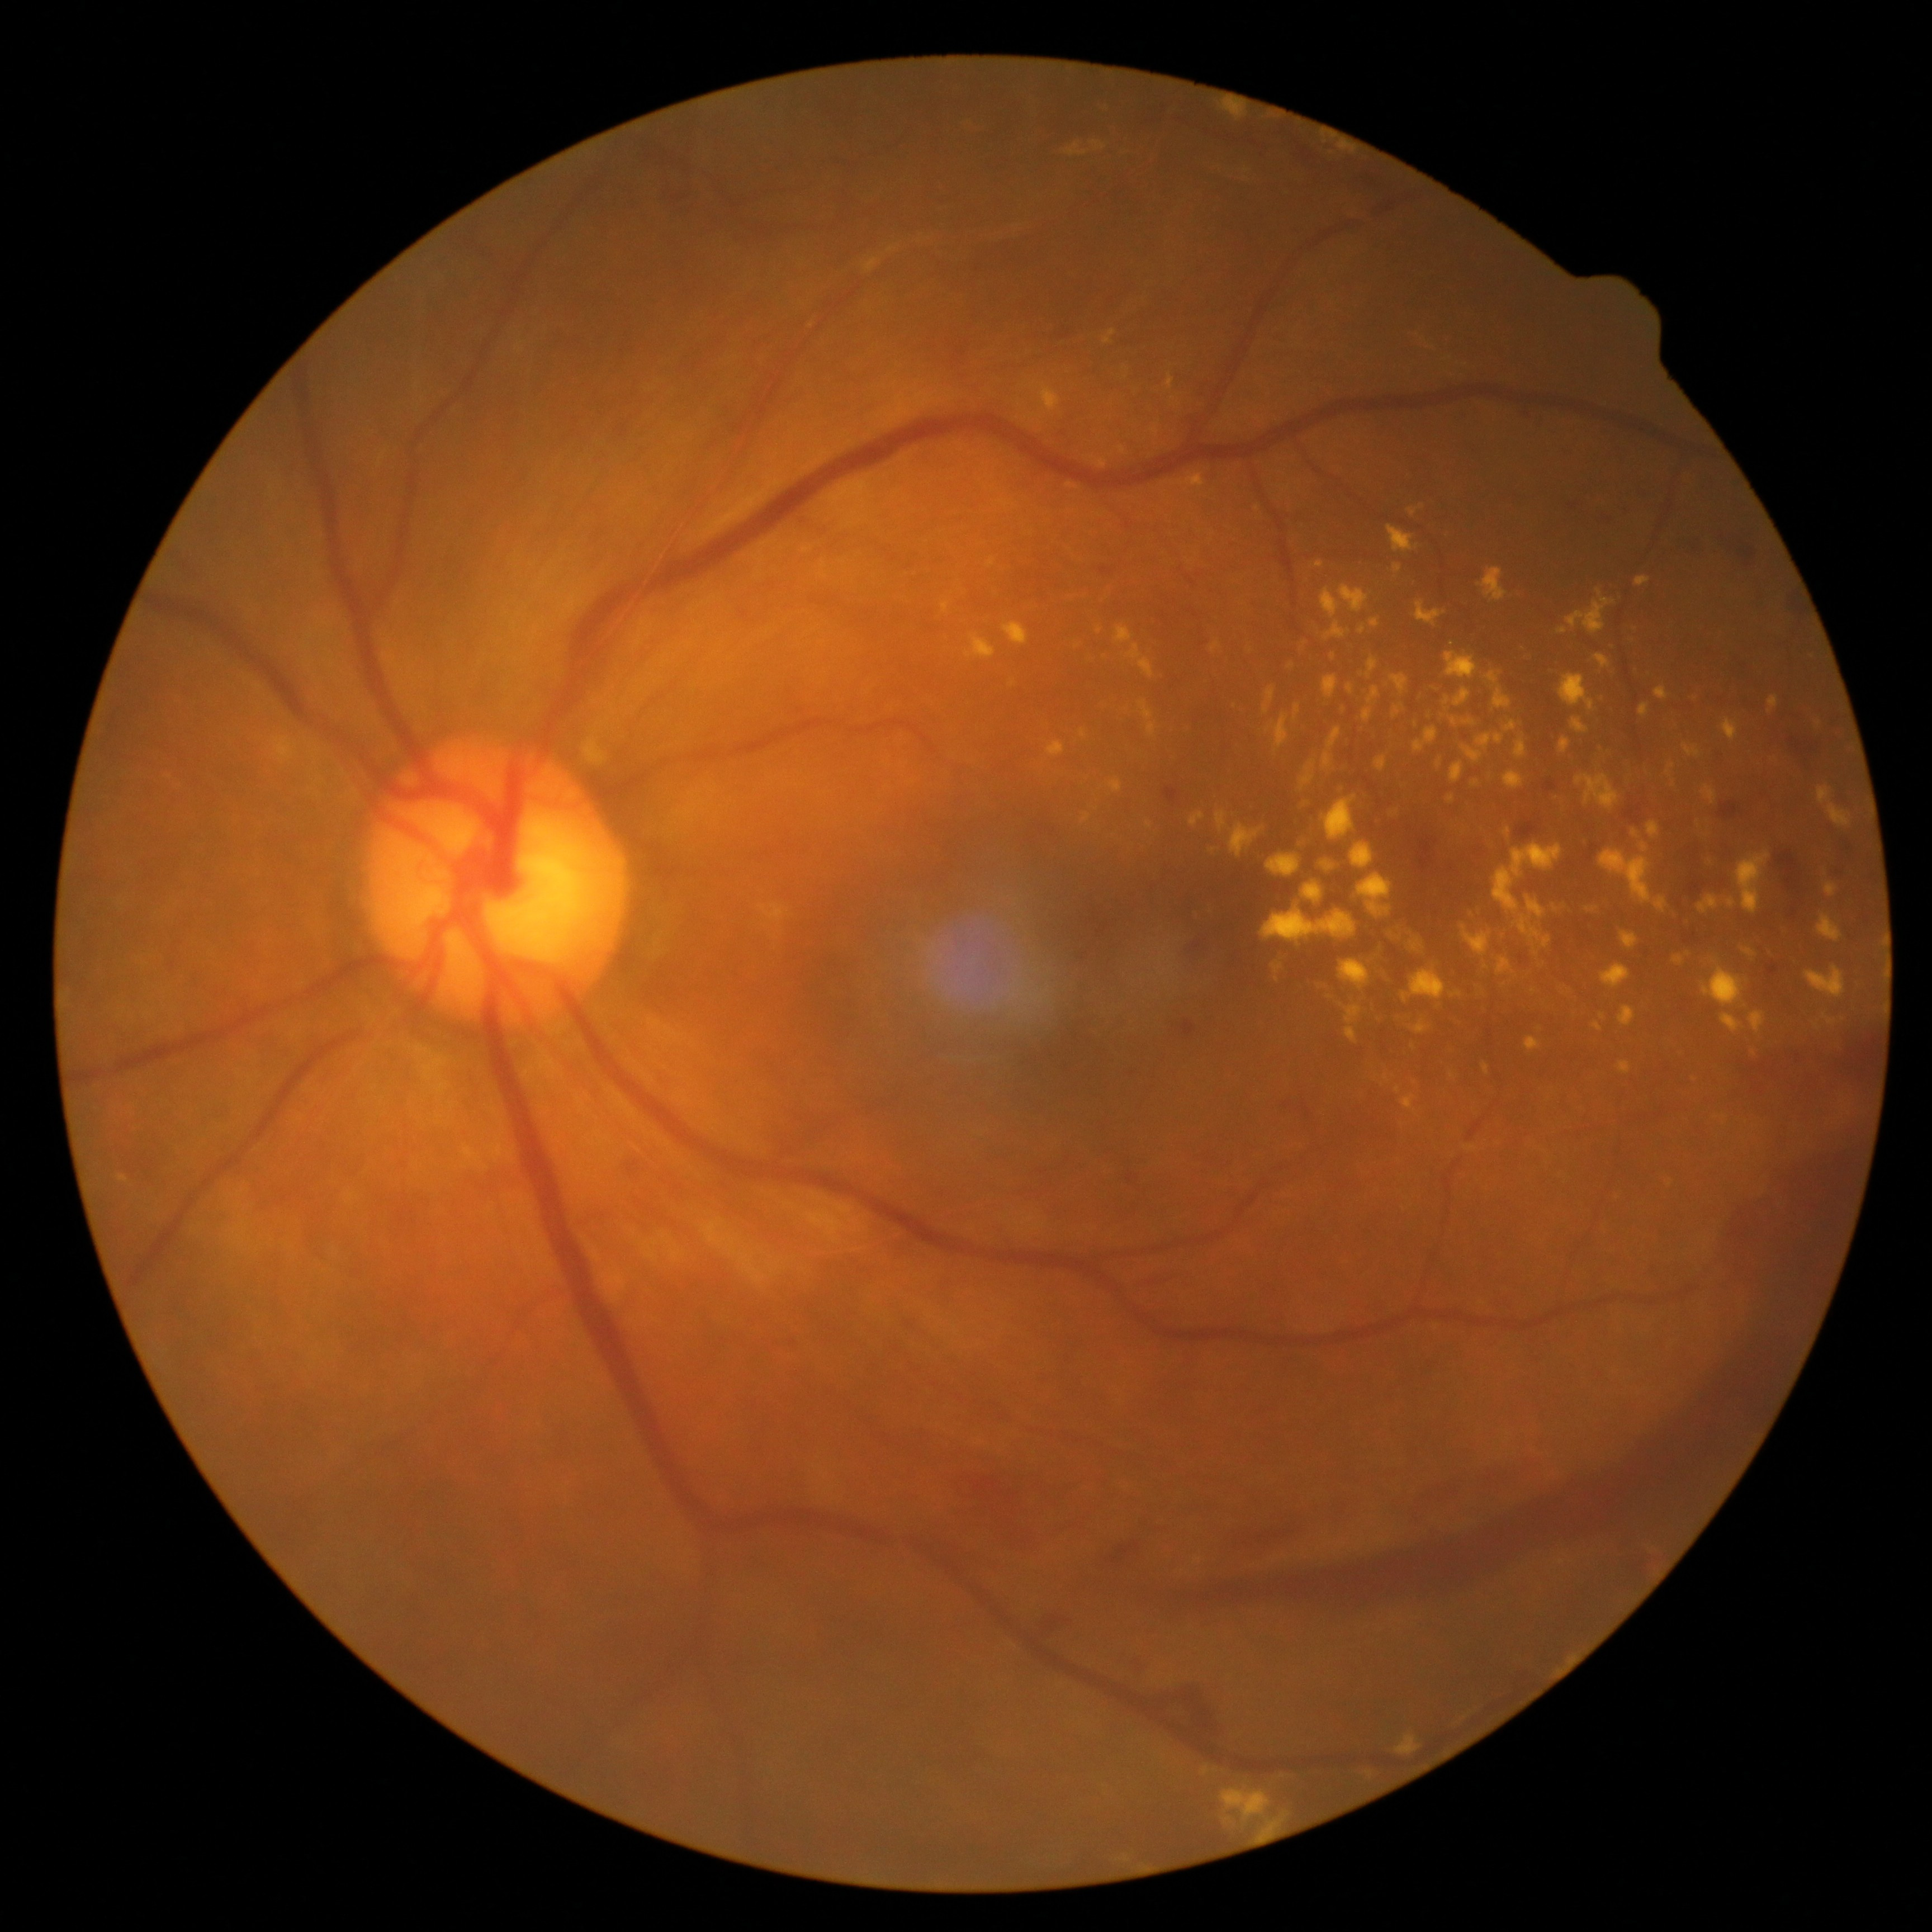
Diabetic retinopathy (DR) is 4/4.
Hemorrhages (HEs) include those at 1143, 1683, 1218, 1745; 1744, 1024, 1881, 1121; 1418, 839, 1437, 873; 1035, 1608, 1075, 1635; 1409, 1459, 1529, 1502; 1560, 497, 1584, 512; 1690, 882, 1706, 895; 1788, 715, 1830, 756; 1777, 851, 1800, 889; 1052, 323, 1071, 337; 1100, 567, 1114, 576; 1546, 780, 1557, 792; 1517, 822, 1539, 839.
Small HEs approximately at Point(1862, 1020).
Hard exudates (EXs) include those at 1416, 600, 1446, 627; 1369, 620, 1380, 629; 1682, 744, 1702, 759; 1389, 923, 1407, 943; 1447, 795, 1456, 803; 1519, 645, 1533, 661; 1093, 456, 1107, 469; 1396, 1734, 1422, 1756; 1301, 760, 1315, 790; 1599, 1014, 1607, 1020; 1125, 645, 1156, 679; 1768, 697, 1779, 713; 1599, 849, 1668, 913; 1640, 704, 1650, 717; 1593, 1022, 1603, 1031; 1576, 774, 1620, 810; 1047, 742, 1066, 759.
Small EXs approximately at Point(1536, 952); Point(1137, 391); Point(1277, 968).